NIDEK AFC-230. 848 by 848 pixels. Retinal fundus photograph:
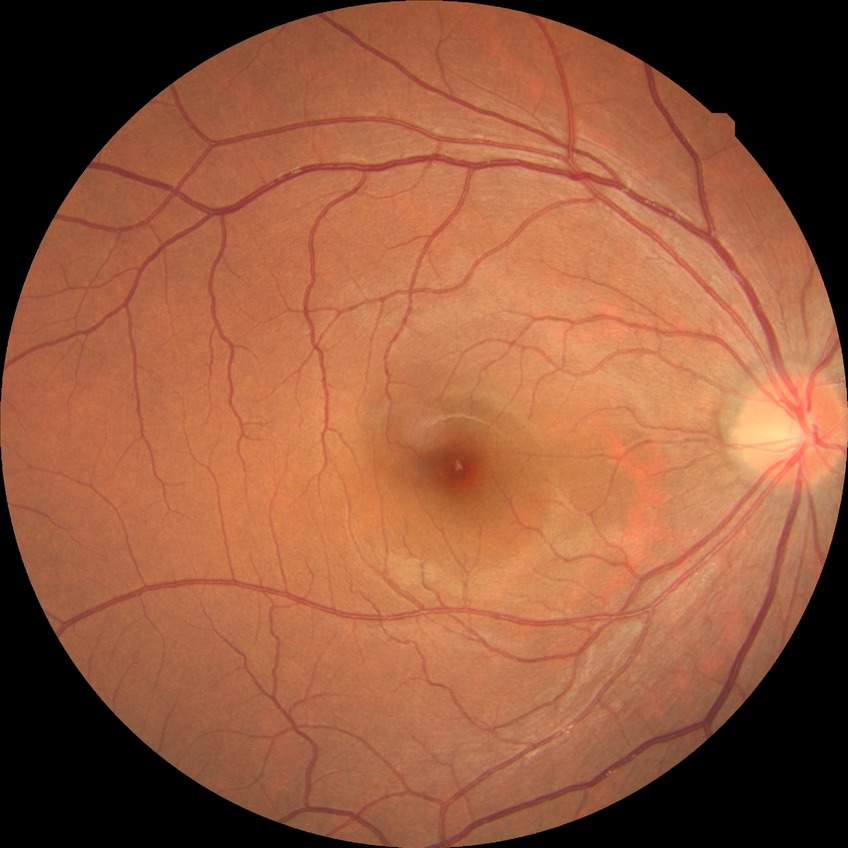

diabetic retinopathy grade@no diabetic retinopathy.